Pediatric wide-field fundus photograph
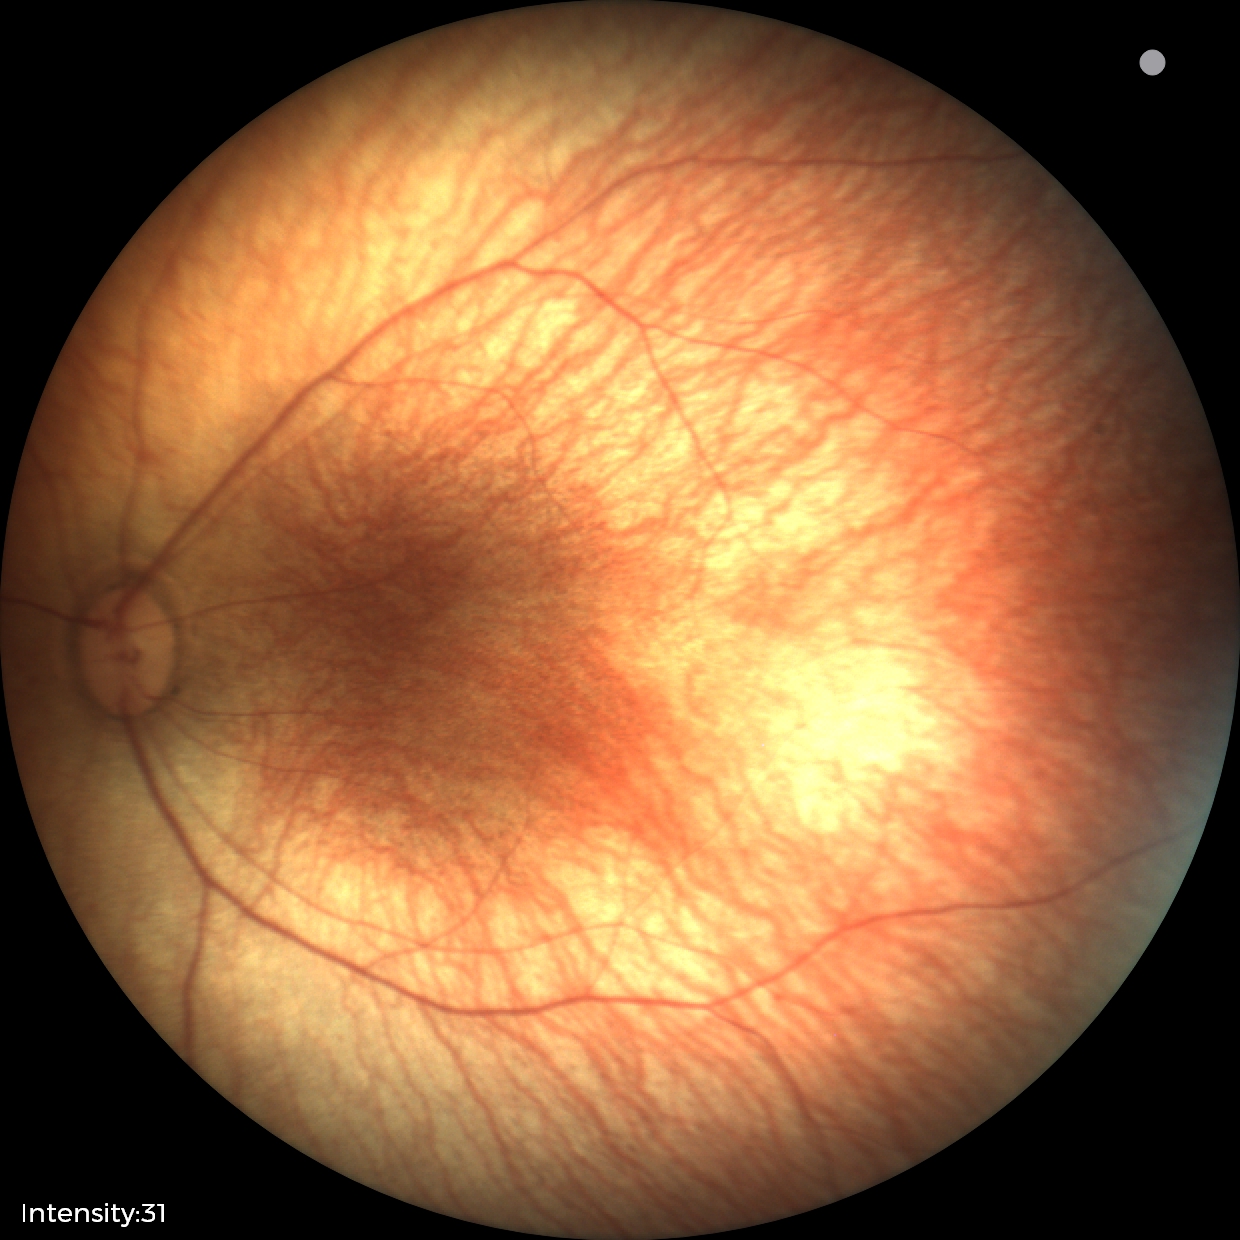 Screening: physiological finding.